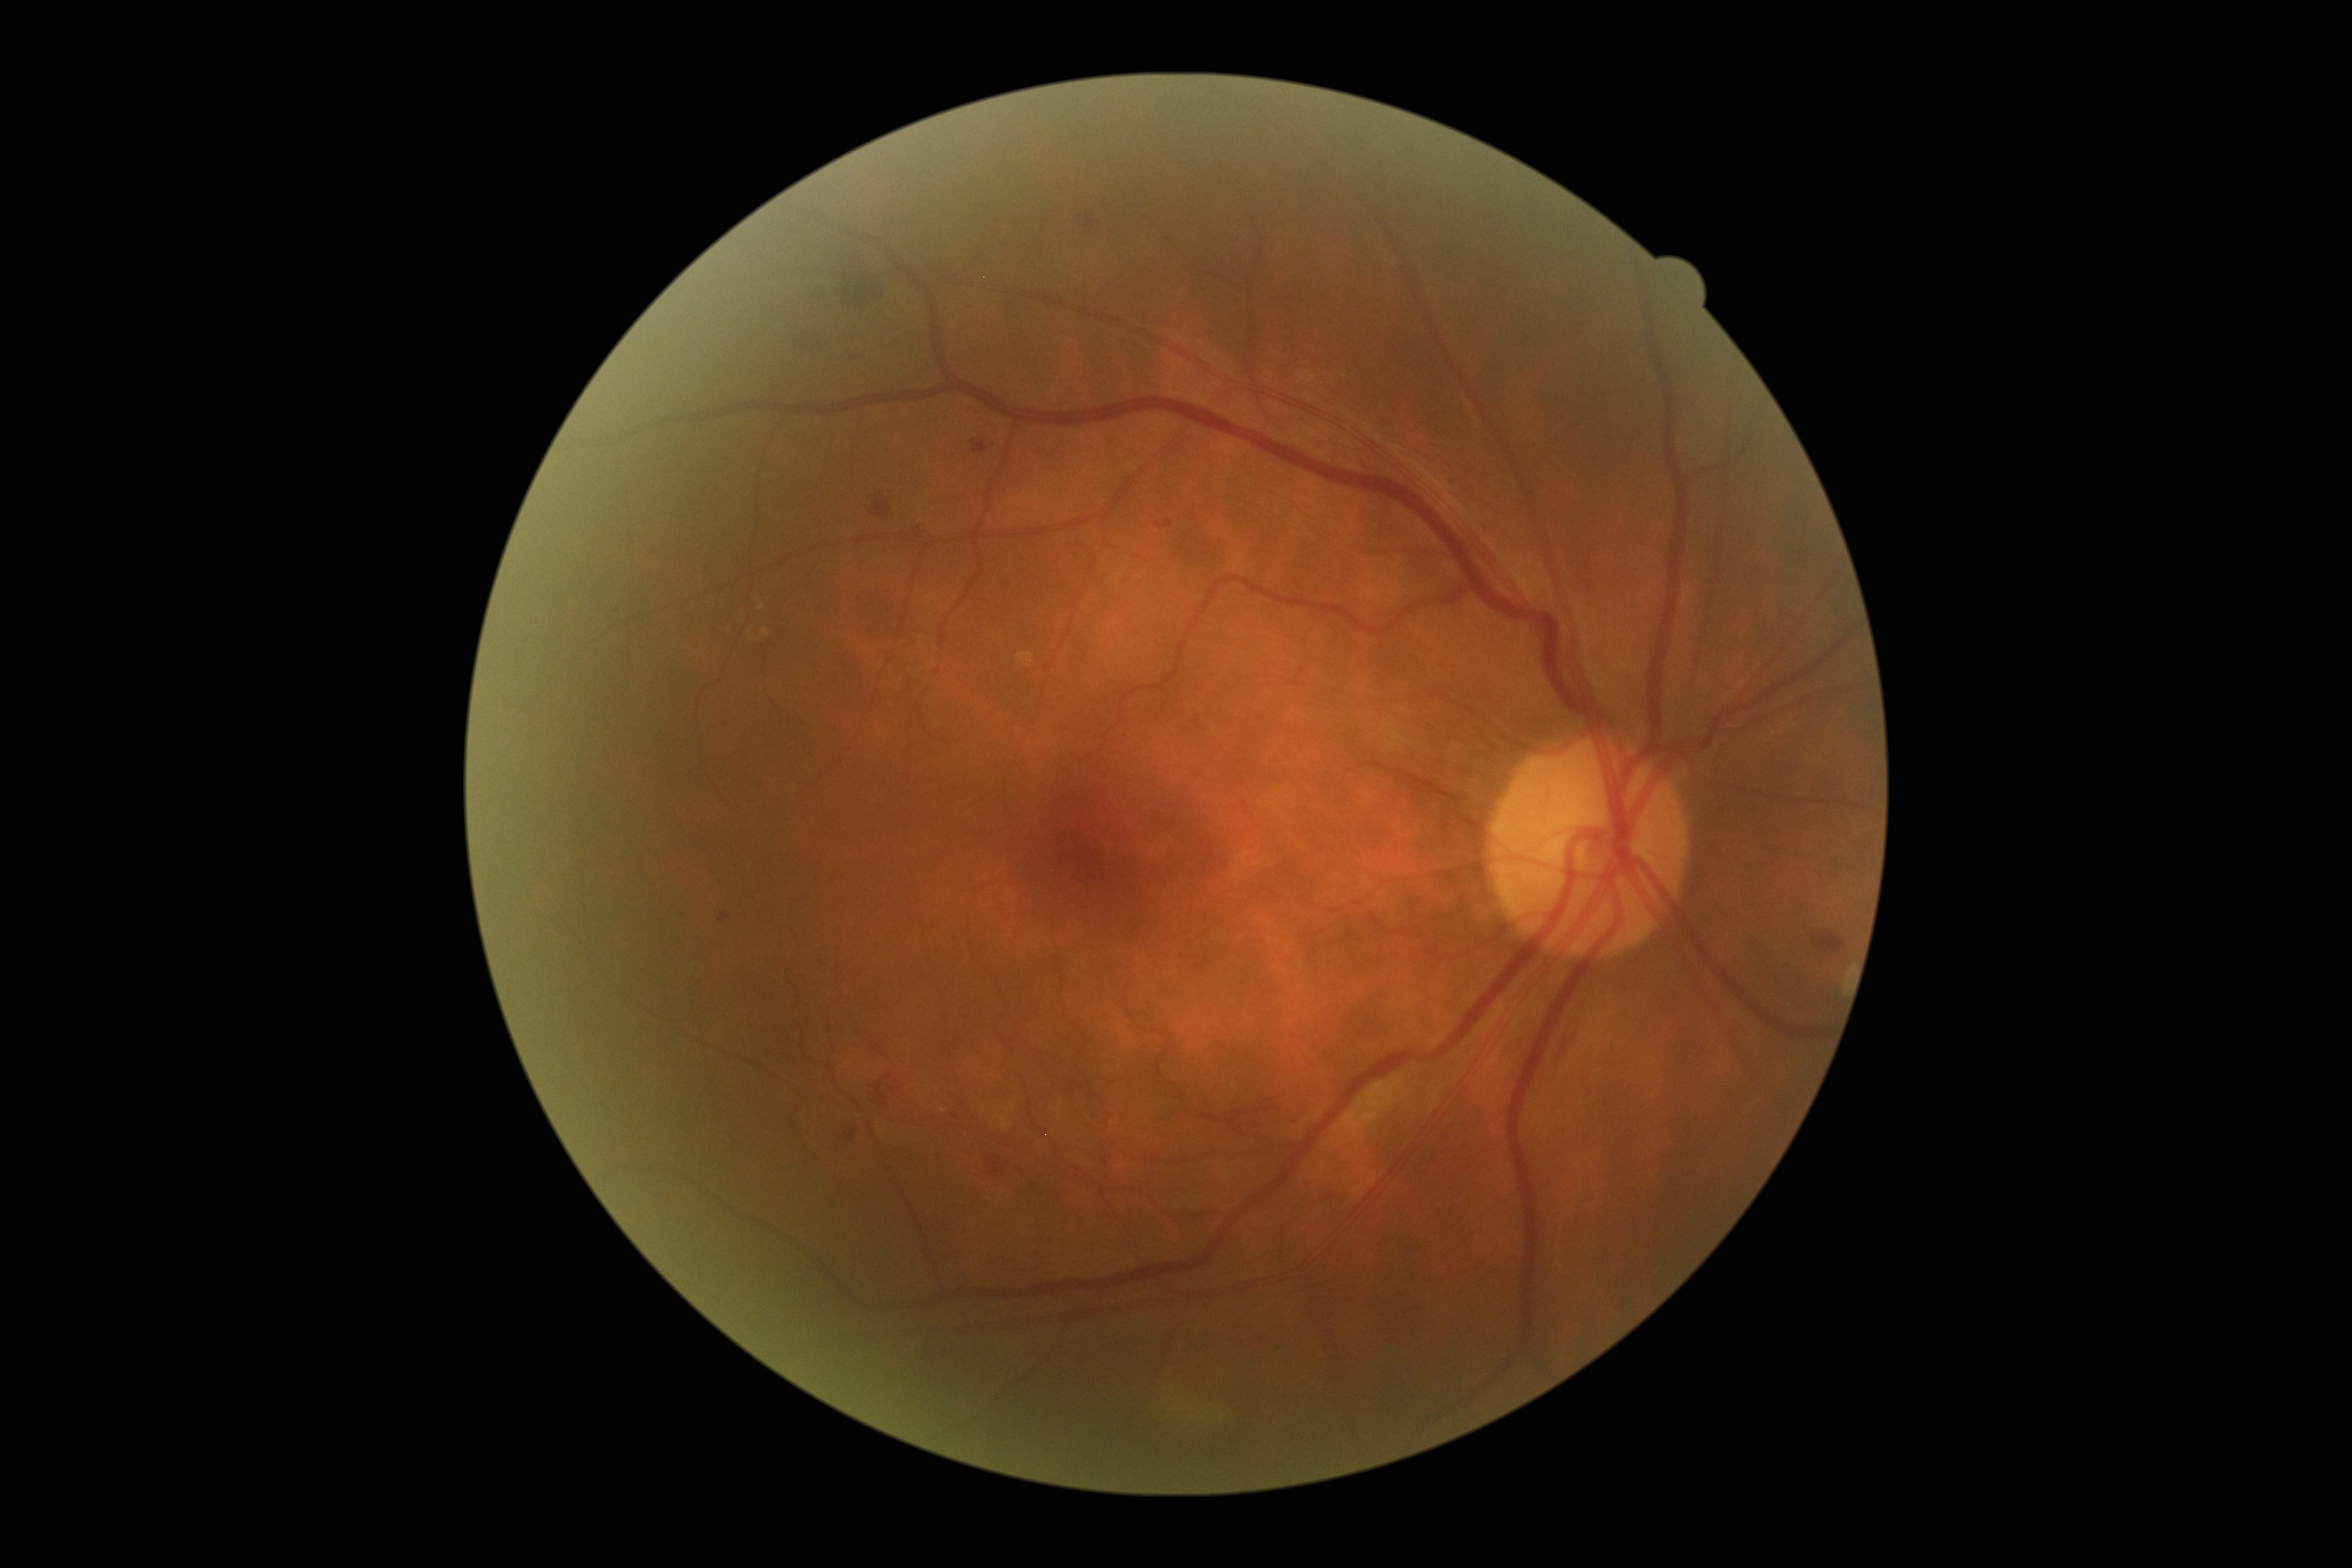 Diabetic retinopathy (DR): moderate non-proliferative diabetic retinopathy (grade 2).